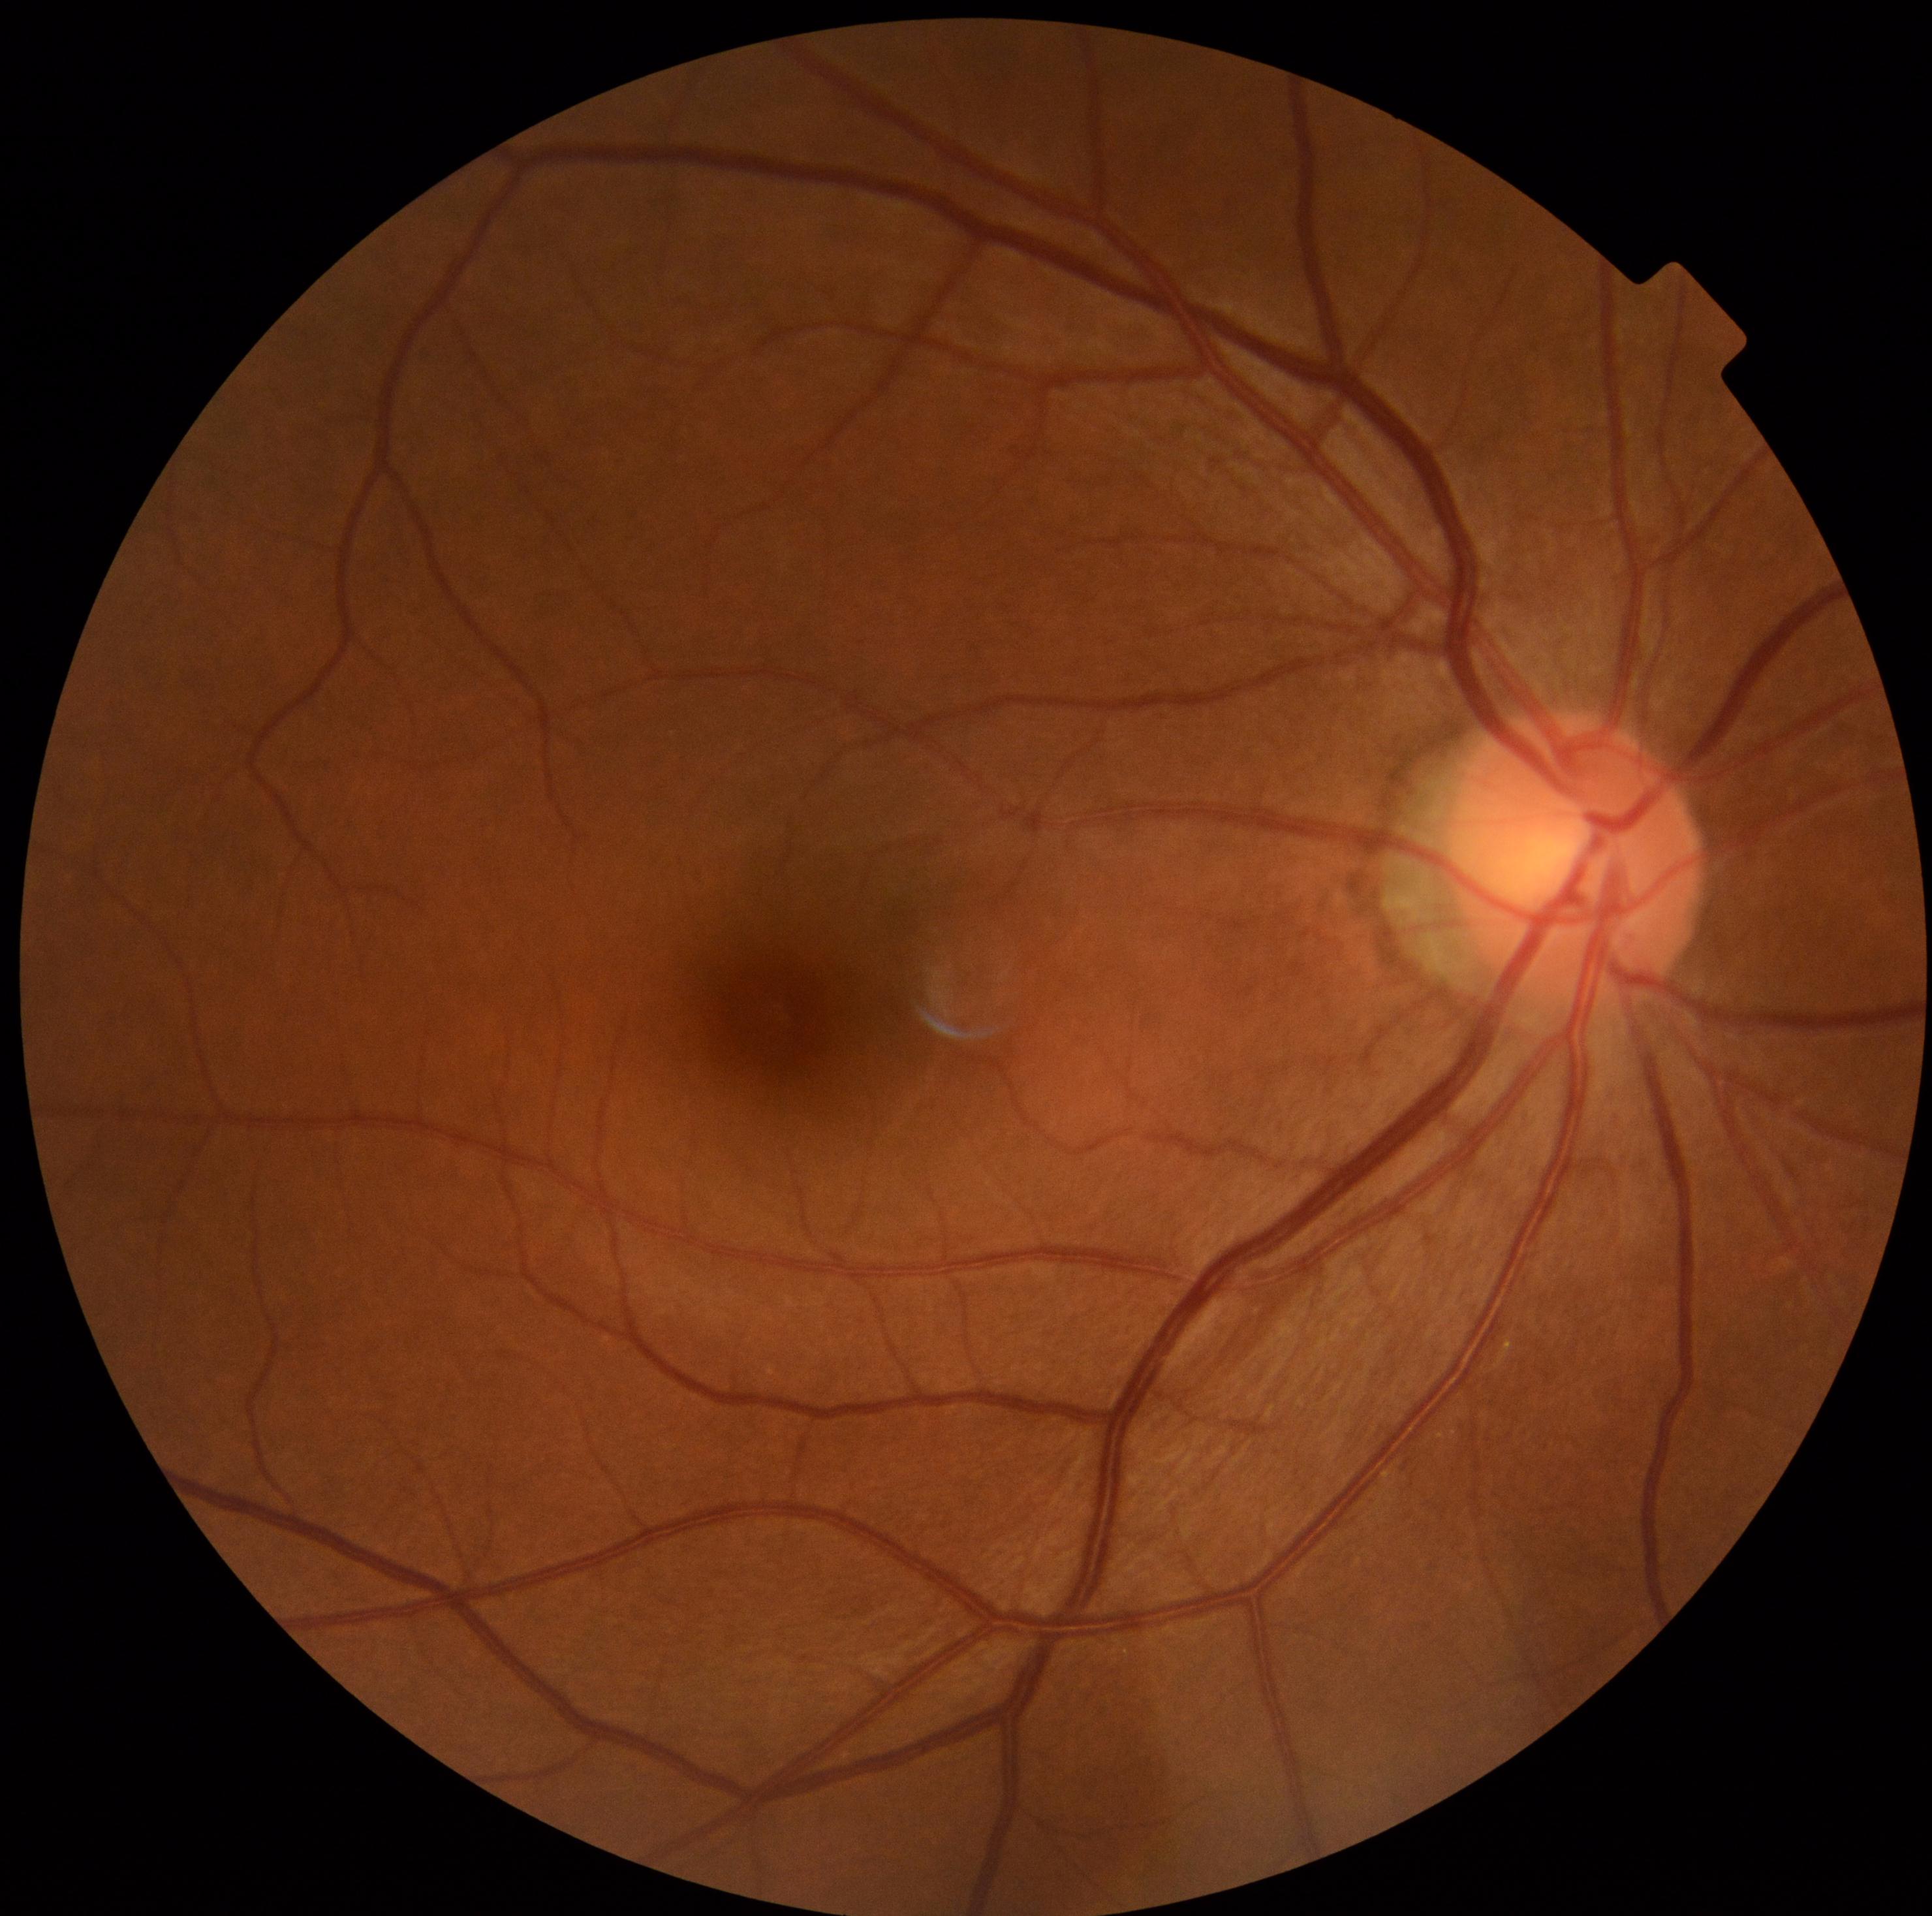
DR severity: grade 0.